45° FOV: 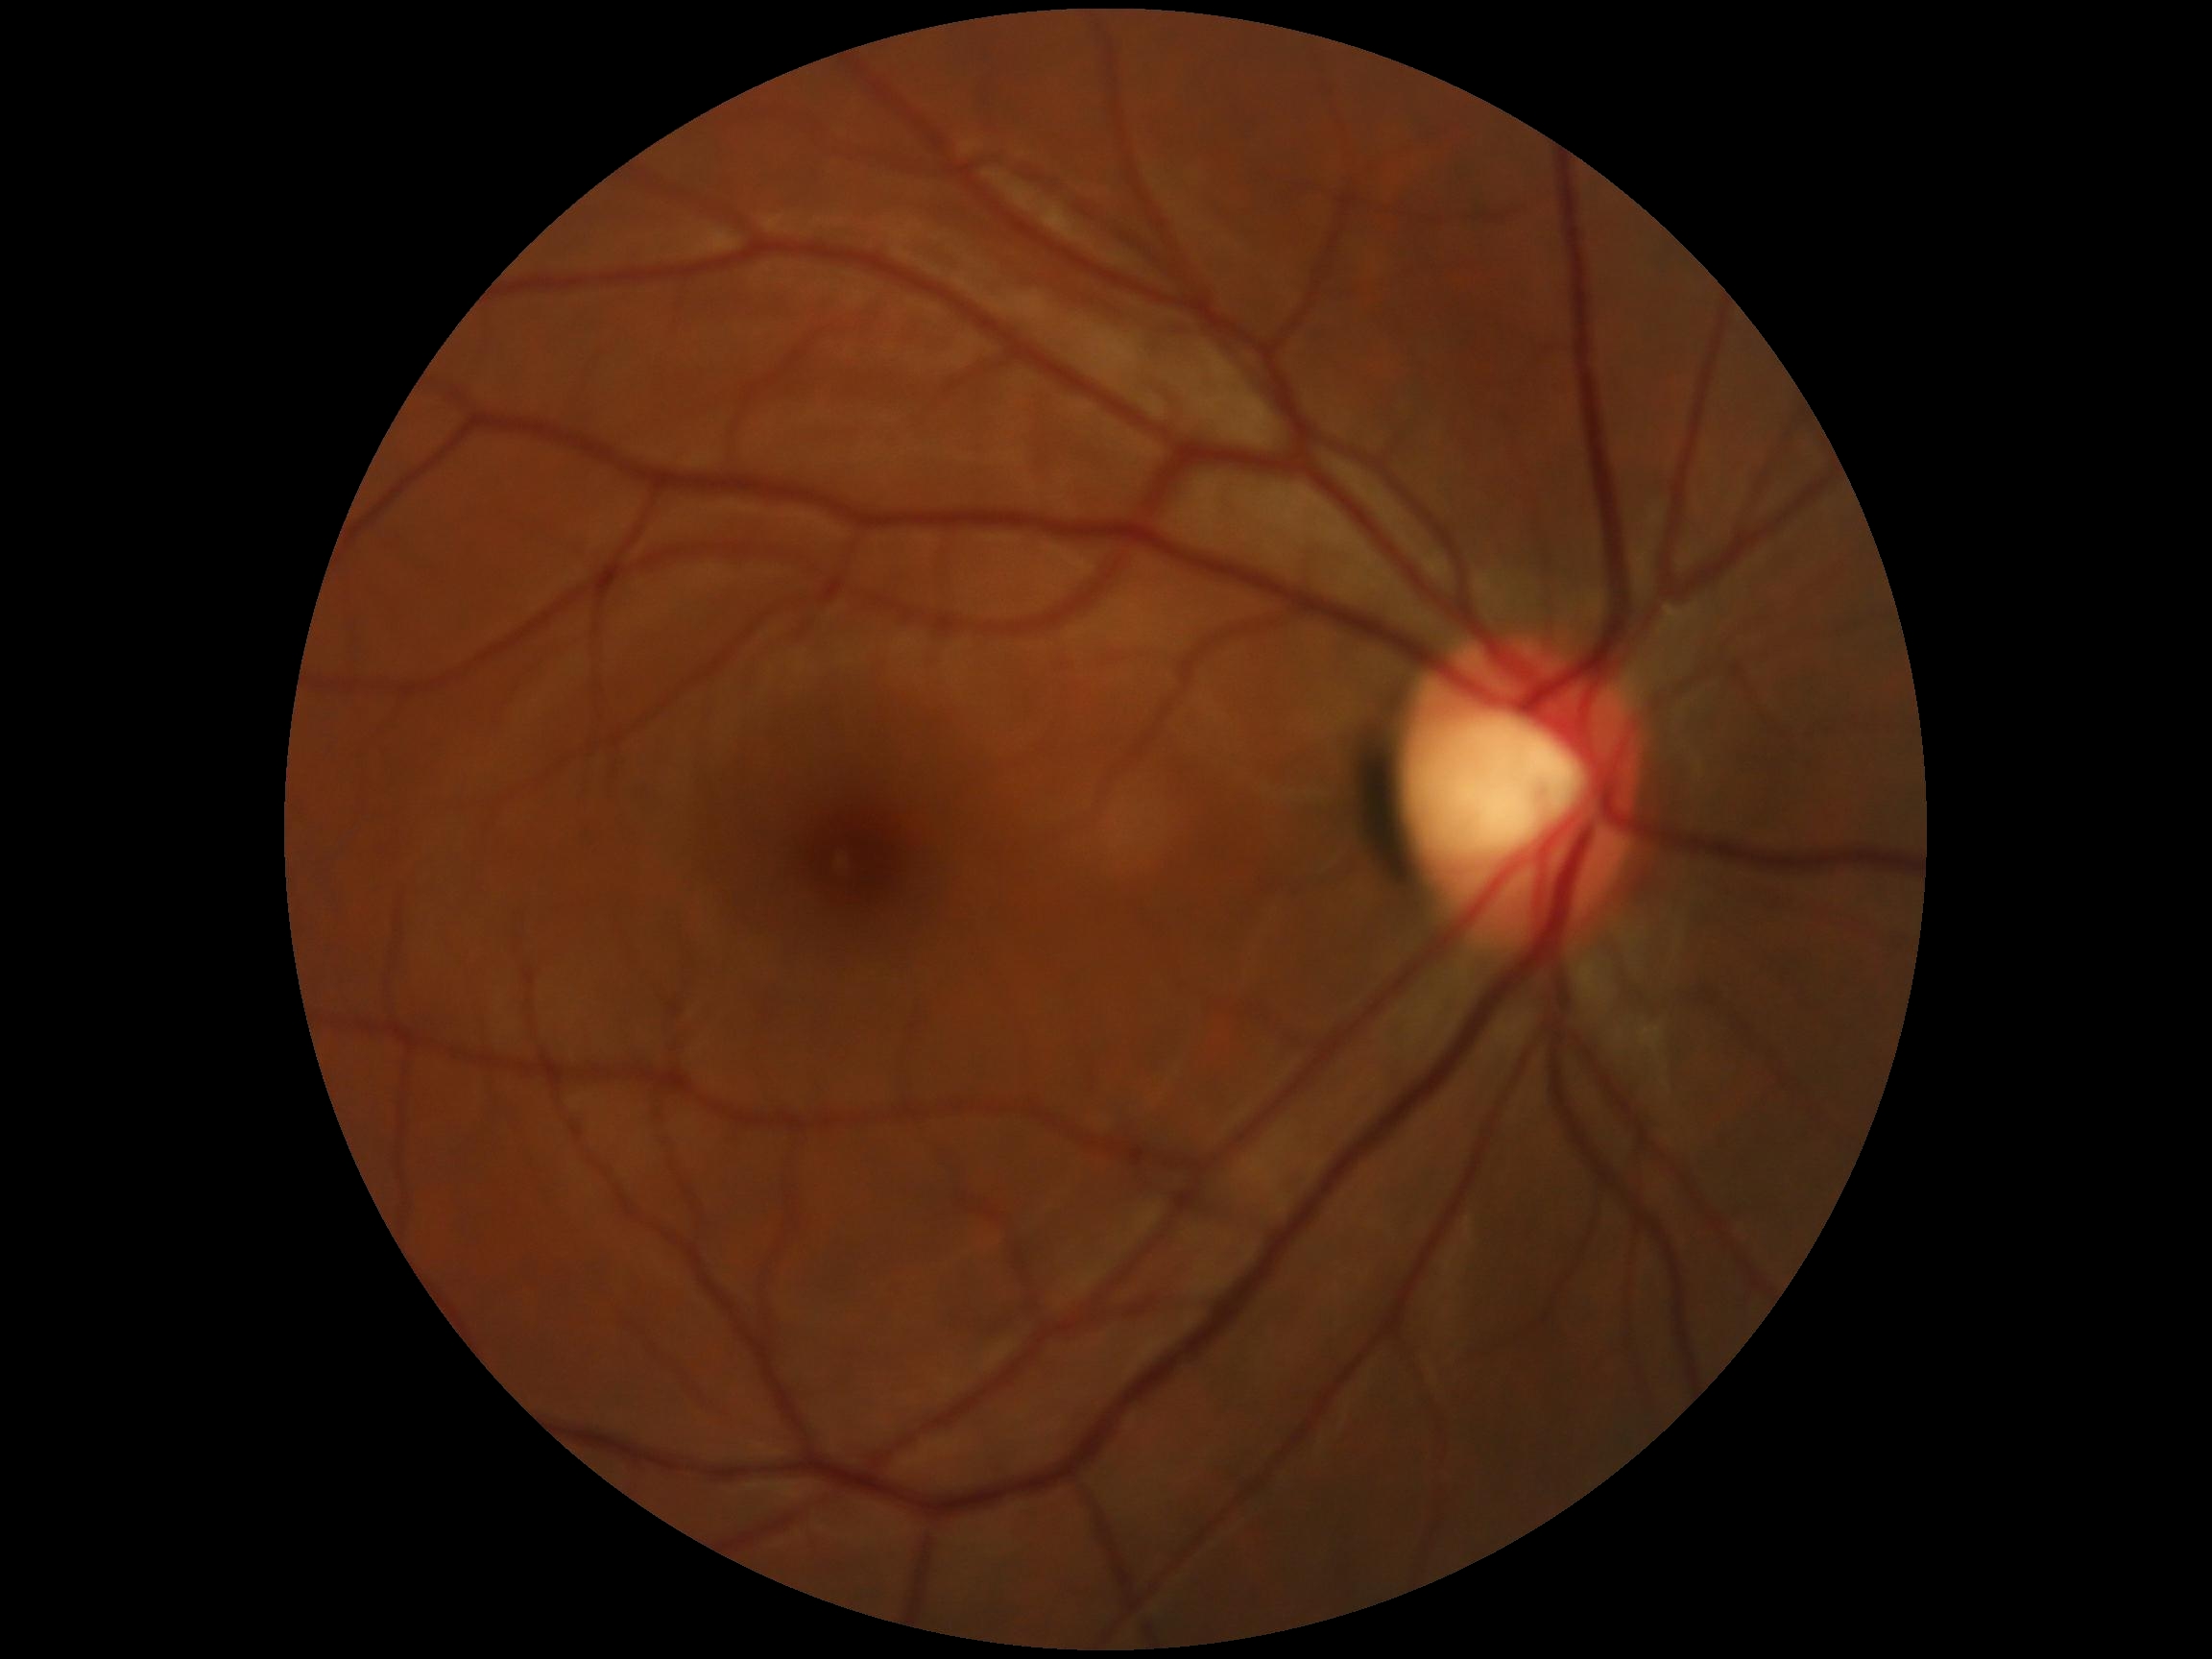 retinopathy: 0/4.